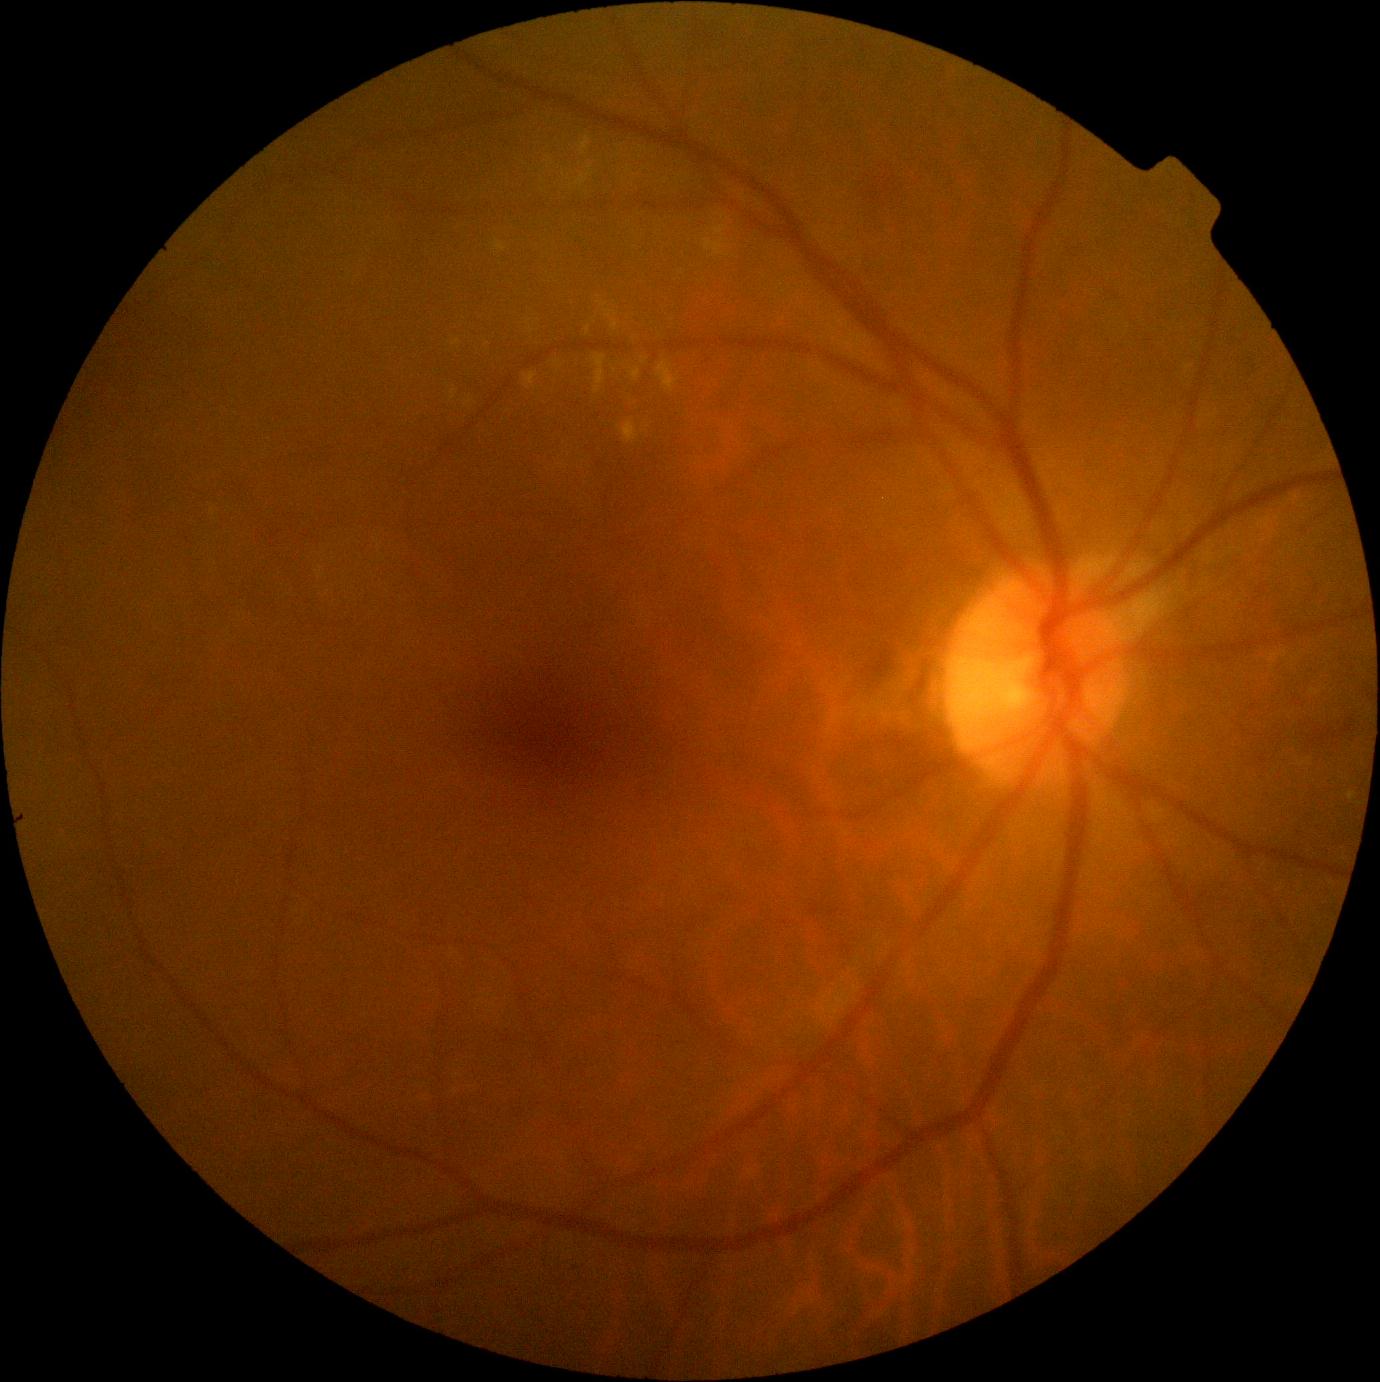

{
  "dr_grade": "grade 2"
}